Nonmydriatic fundus photograph
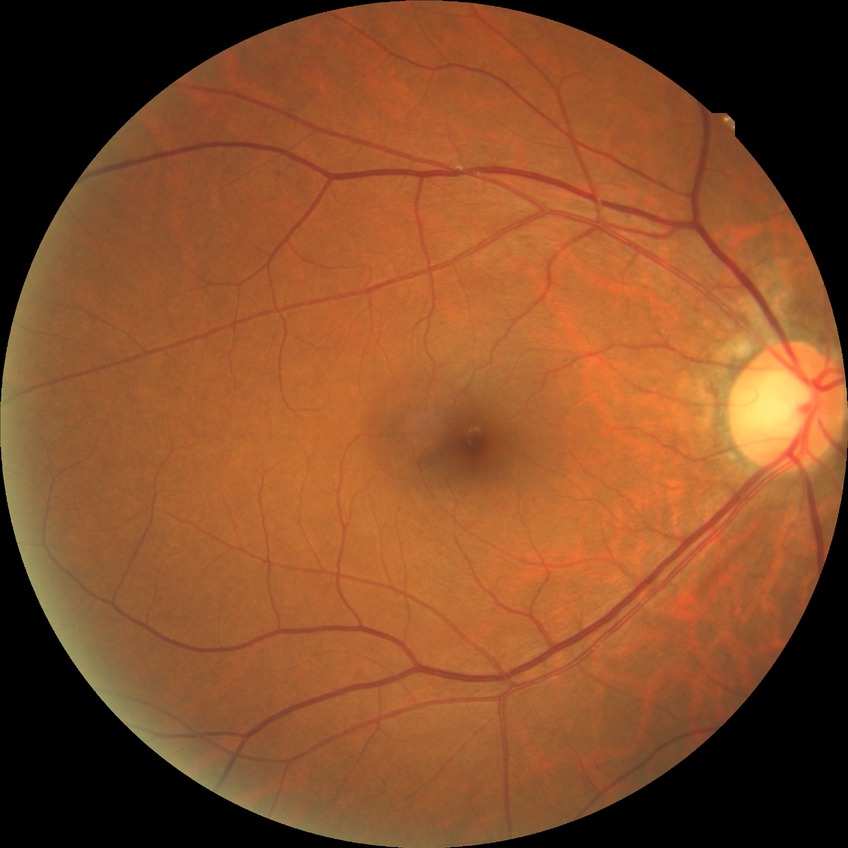
Diabetic retinopathy (DR): NDR (no diabetic retinopathy).